Posterior pole photograph · 848x848px: 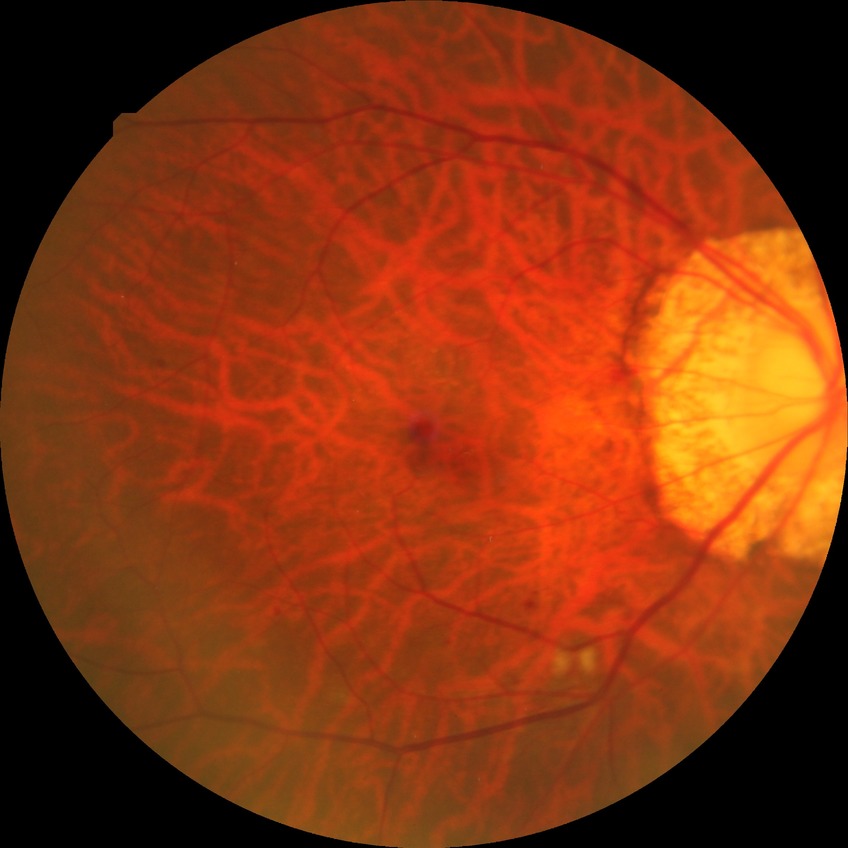
Diabetic retinopathy (DR) is pre-proliferative diabetic retinopathy (PPDR).
The retinopathy is classified as non-proliferative diabetic retinopathy.